CFP. Nonmydriatic. 45 degree fundus photograph. Image size 848x848:
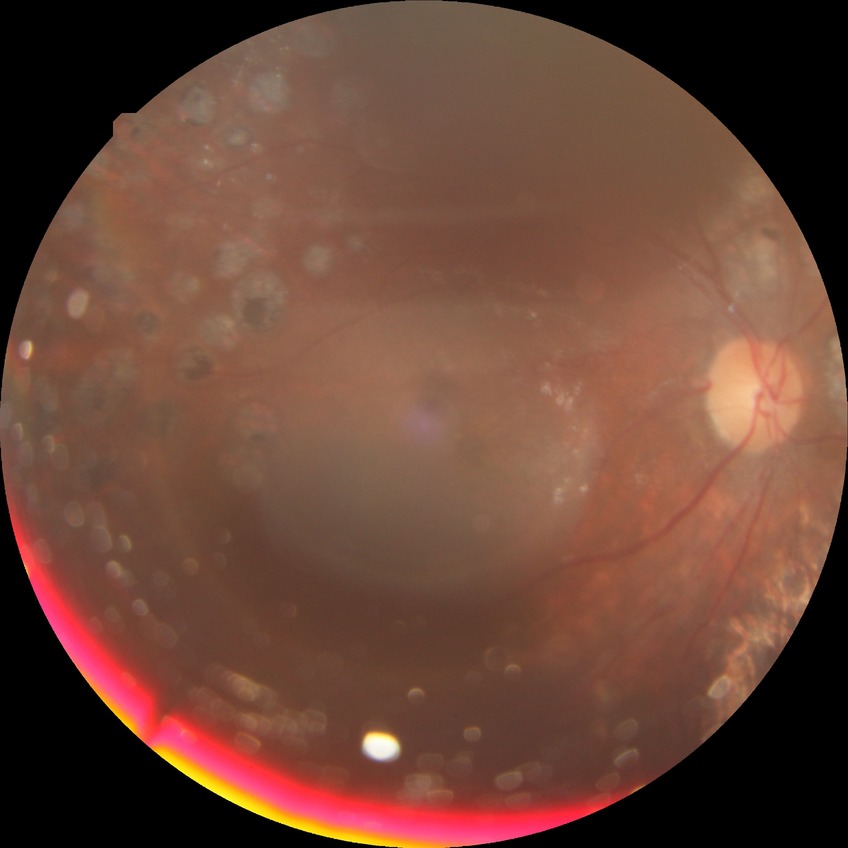
diabetic retinopathy (DR) = proliferative diabetic retinopathy (PDR).